Retinal fundus photograph.
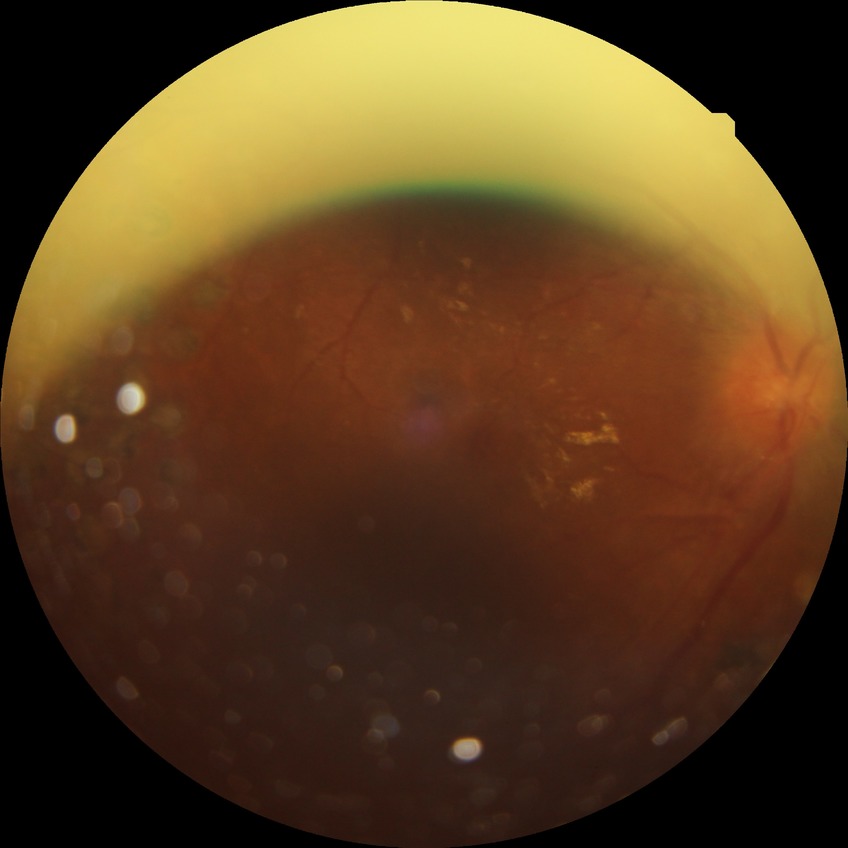
  davis_grade: PDR (proliferative diabetic retinopathy)